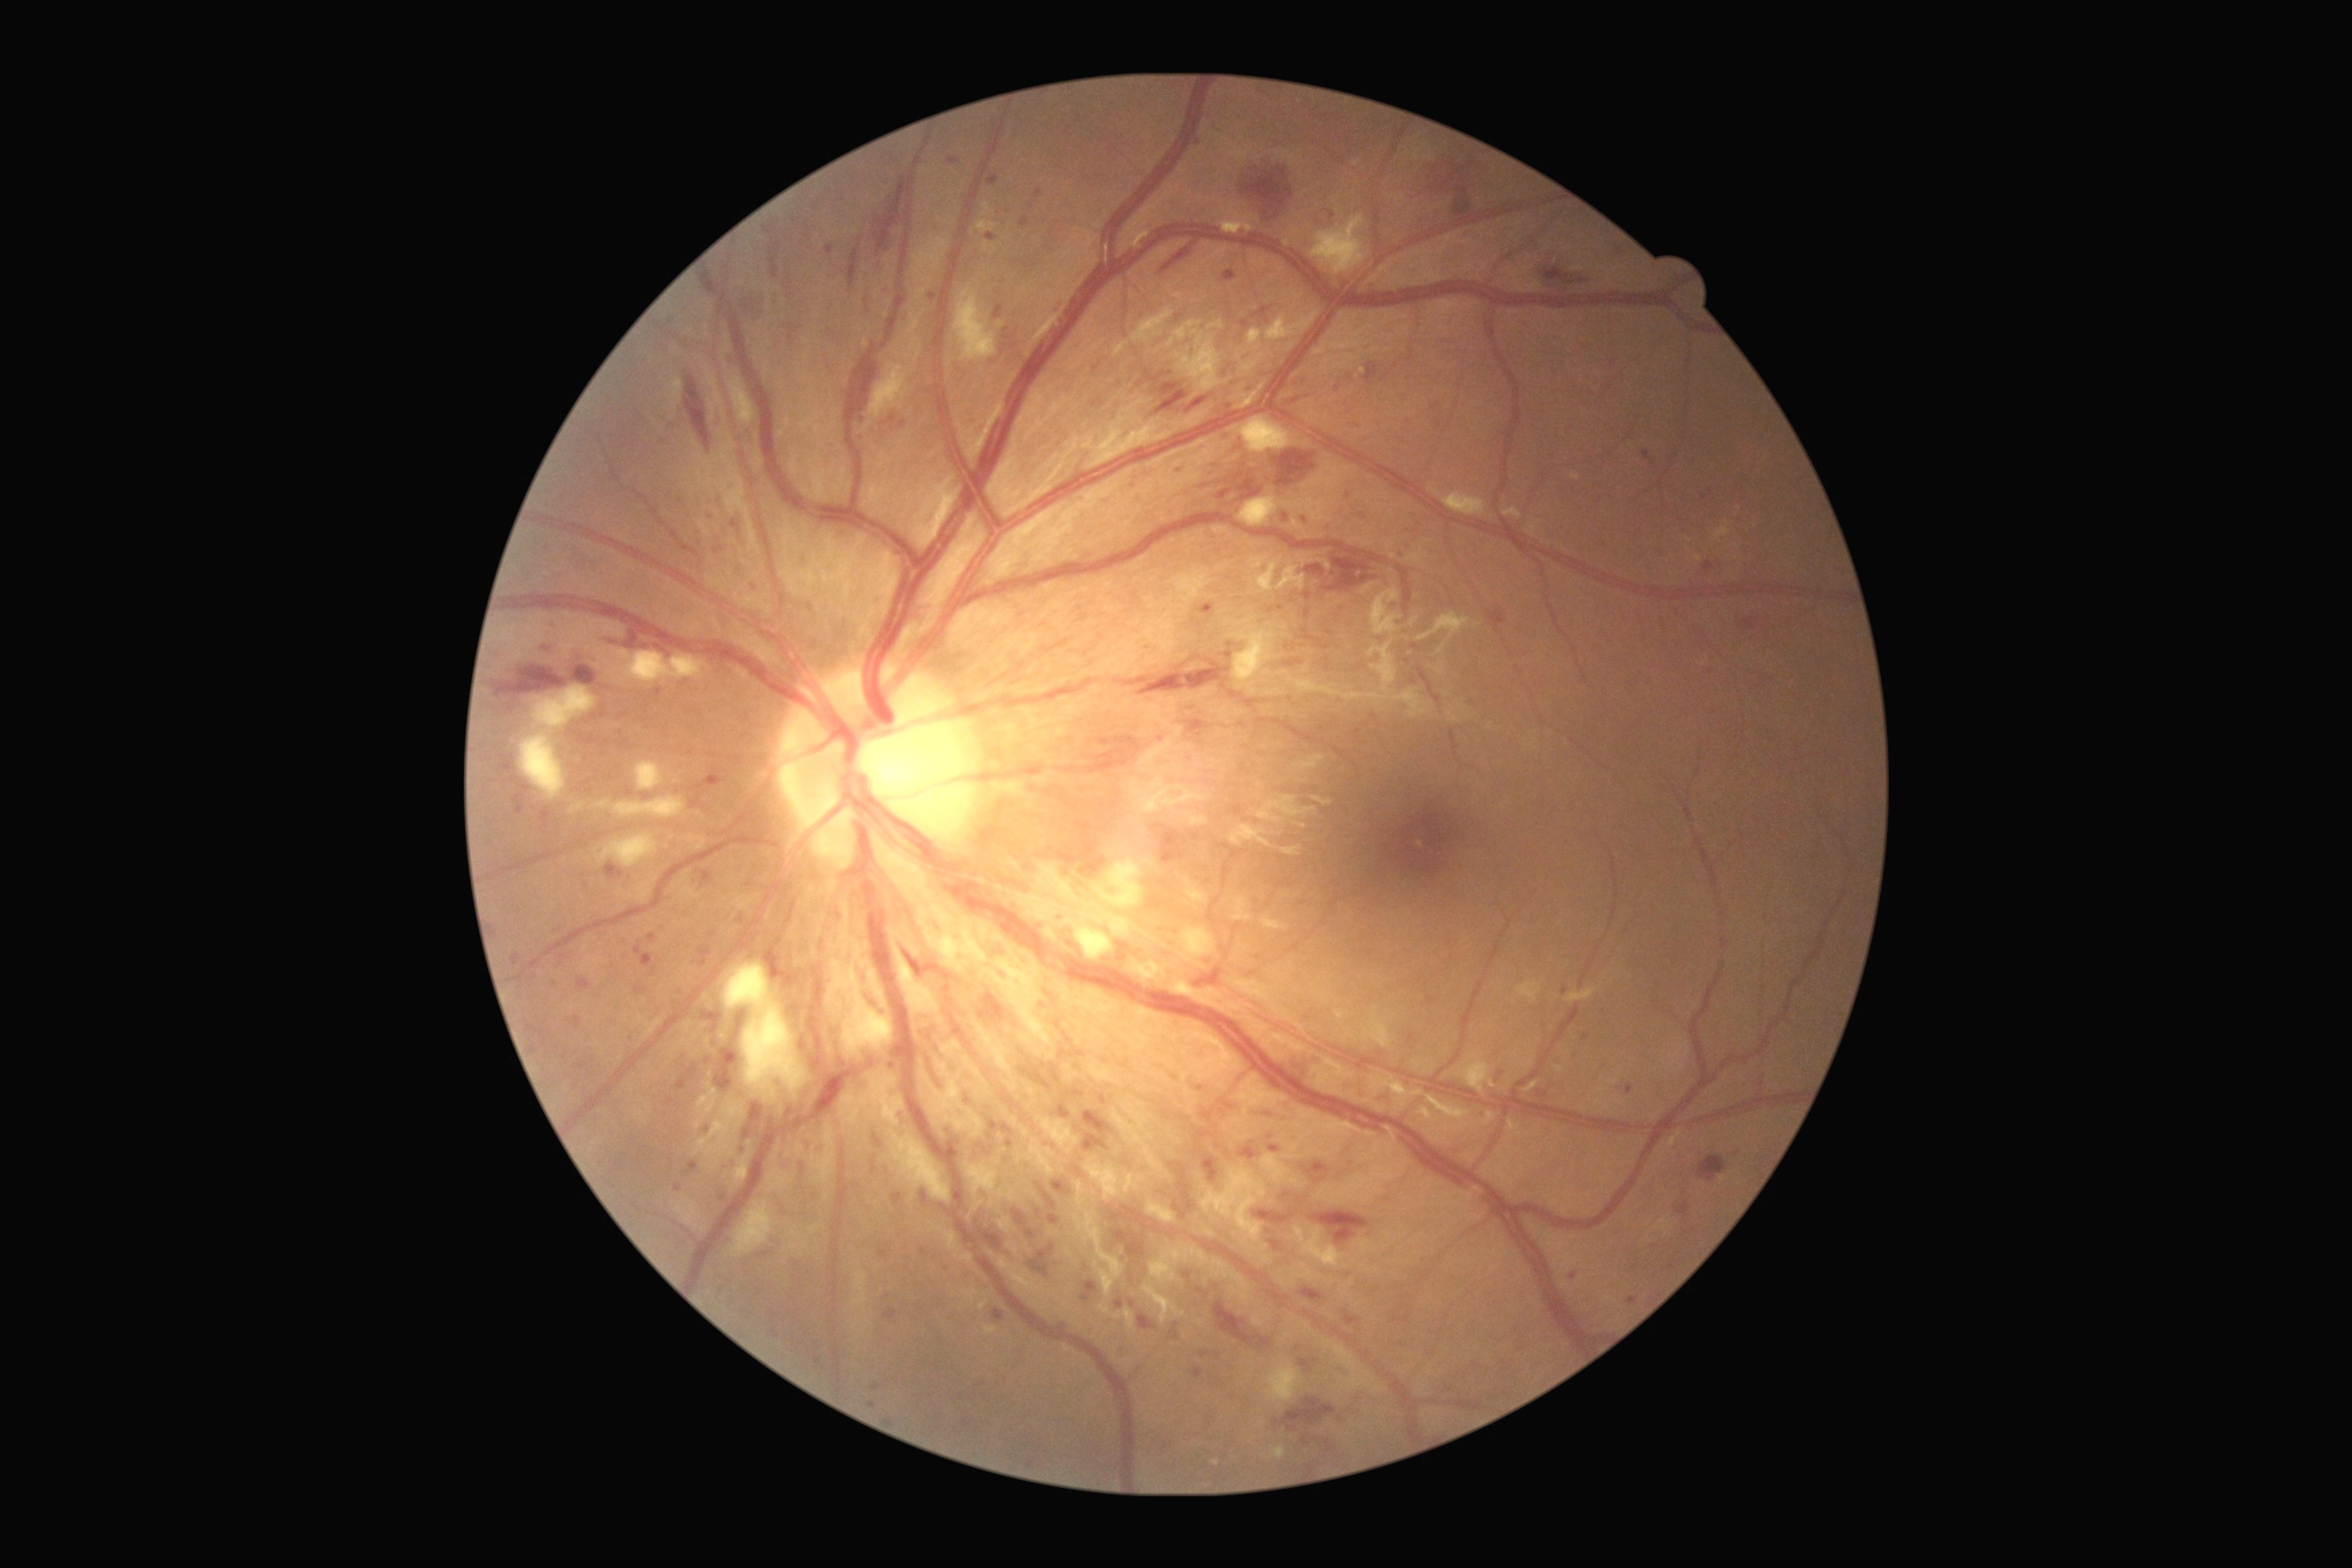

Diabetic retinopathy grade is 3 (severe NPDR)
Selected lesions:
* microaneurysms (continued): bbox=(1240, 723, 1248, 729), bbox=(667, 427, 676, 435), bbox=(1224, 652, 1233, 660), bbox=(1028, 1458, 1037, 1467), bbox=(1200, 603, 1215, 616), bbox=(500, 754, 514, 774), bbox=(1037, 1184, 1055, 1208), bbox=(994, 1309, 1004, 1322), bbox=(1220, 375, 1230, 378), bbox=(1162, 1442, 1170, 1449), bbox=(990, 1121, 999, 1132), bbox=(985, 233, 995, 244)
* Small microaneurysms near (x=565, y=1058), (x=892, y=1066), (x=1712, y=672), (x=1305, y=521), (x=534, y=977), (x=992, y=1138), (x=670, y=1103)